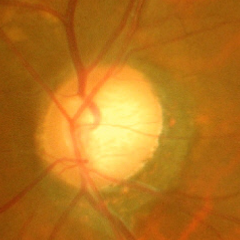

Showing advanced-stage glaucoma.